Retinal fundus photograph.
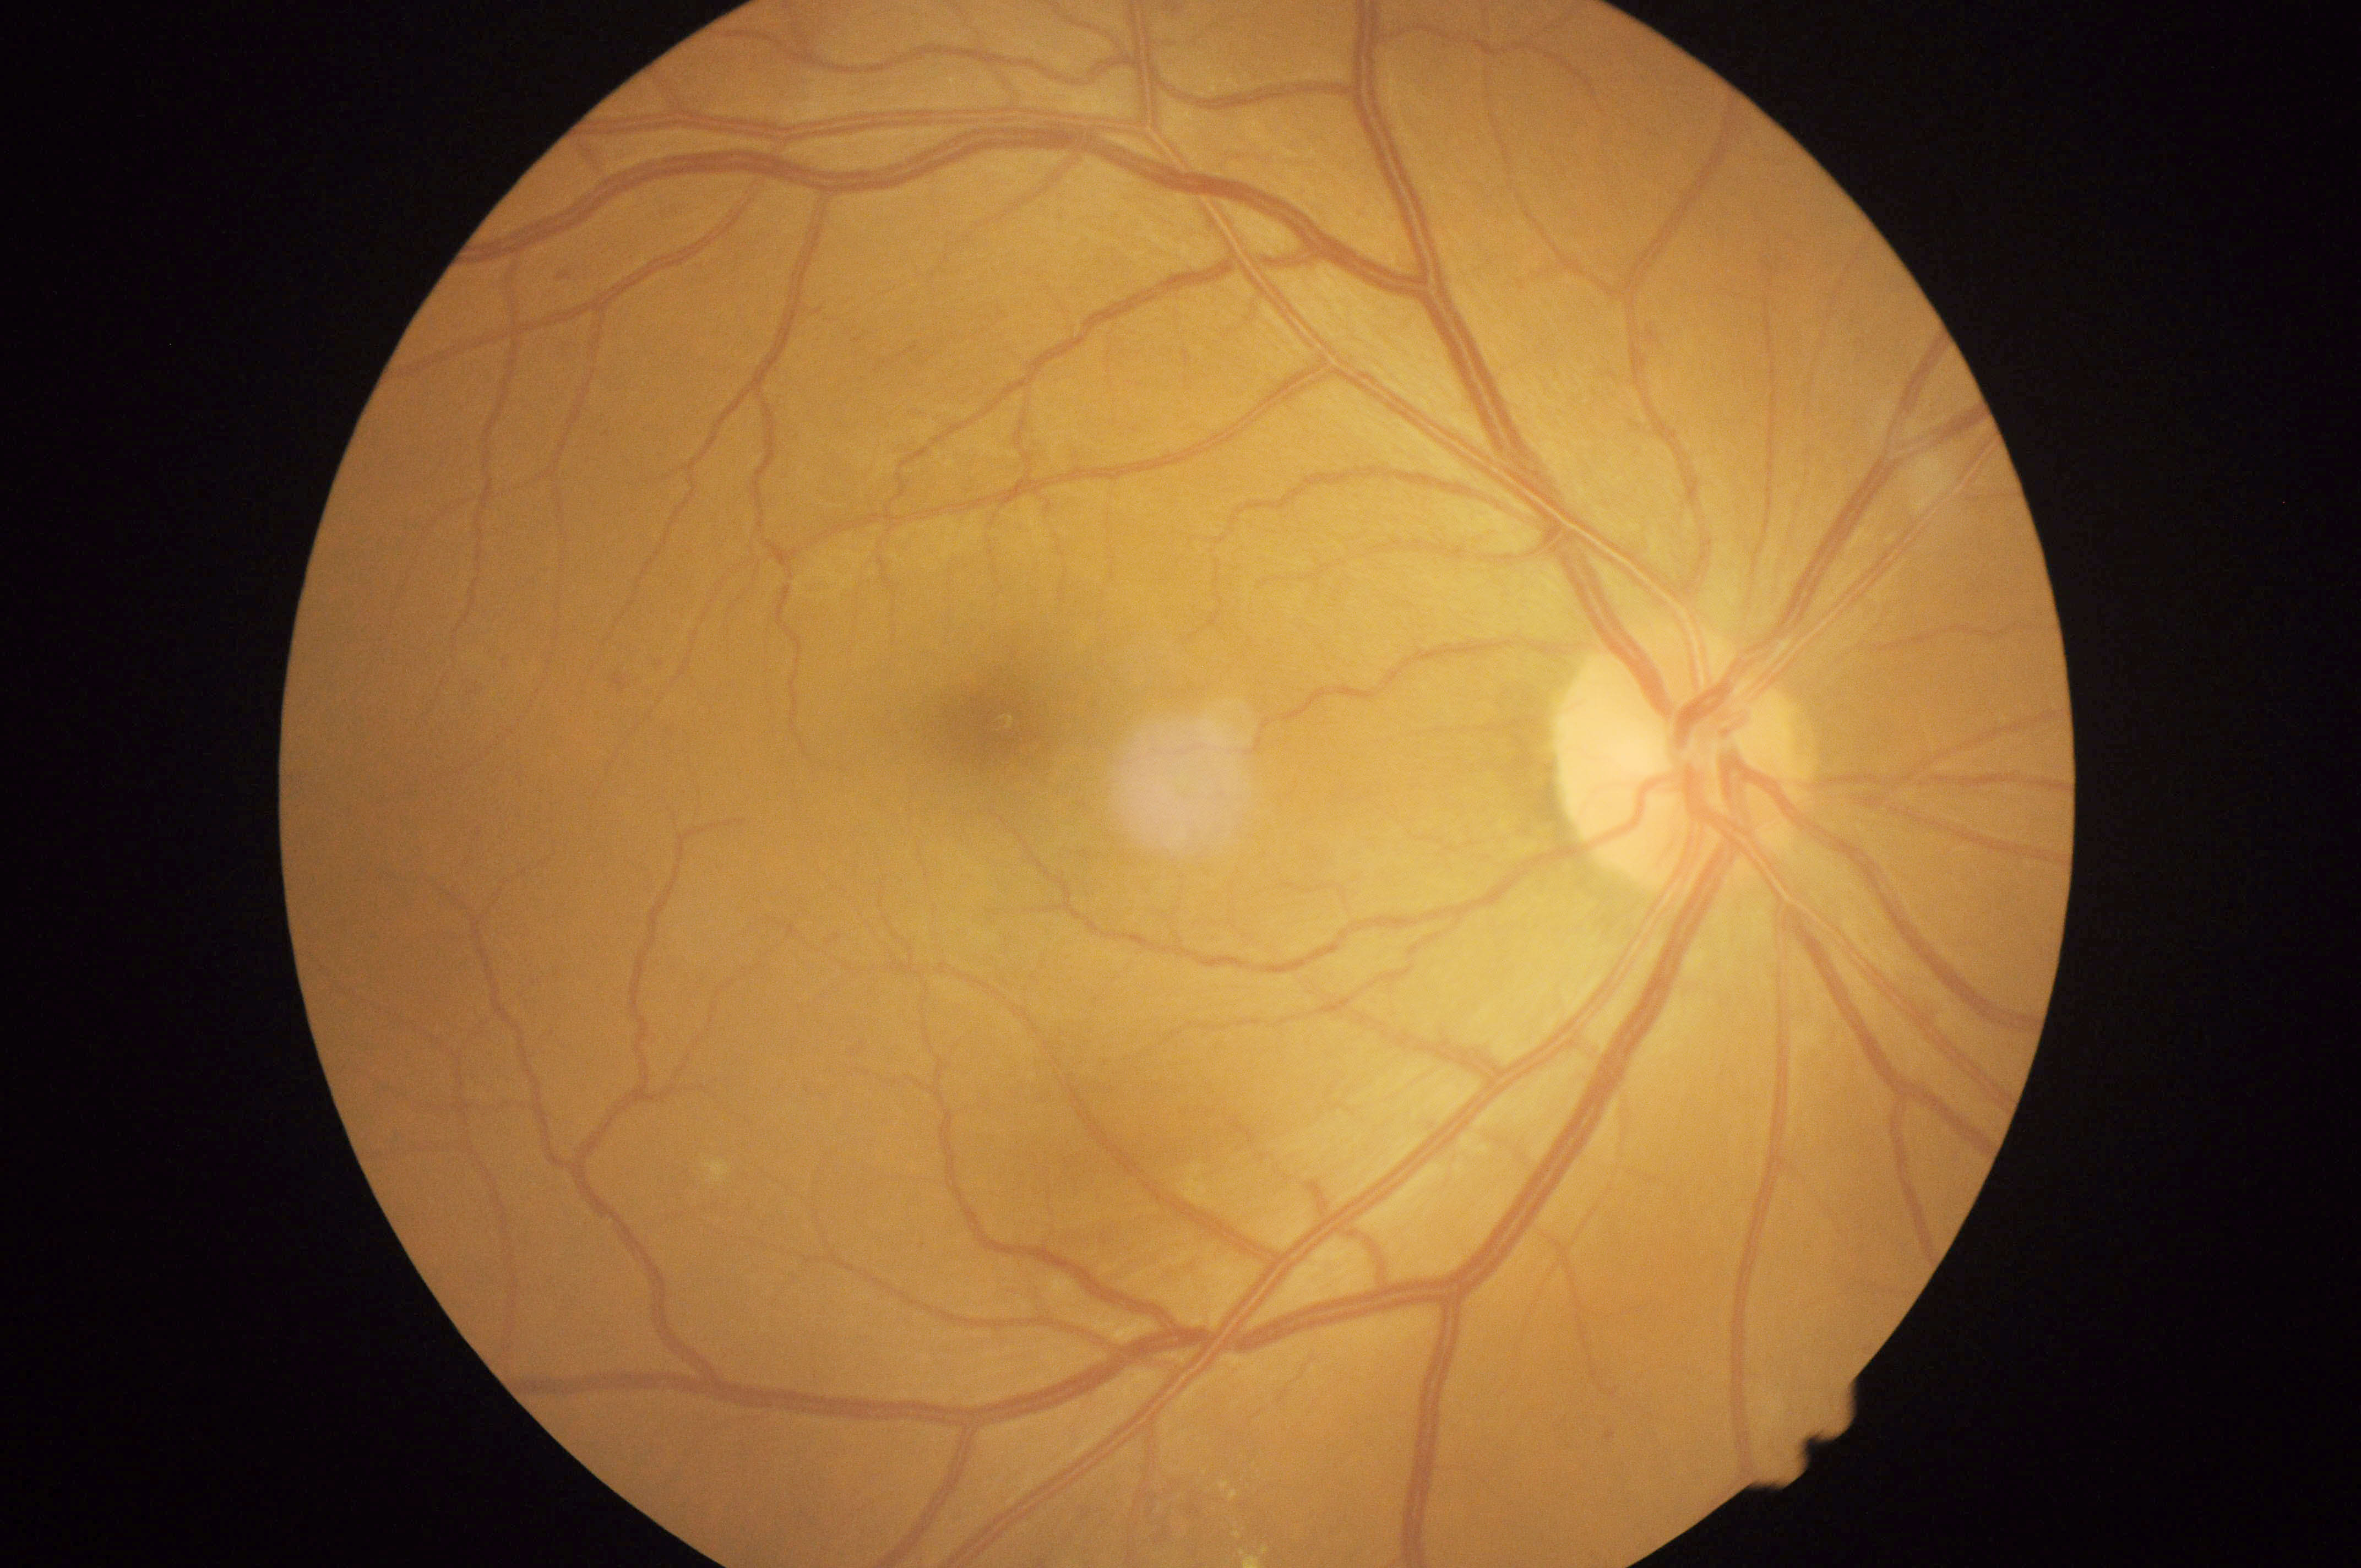 dr_grade: 2 (moderate NPDR)